45-degree field of view — 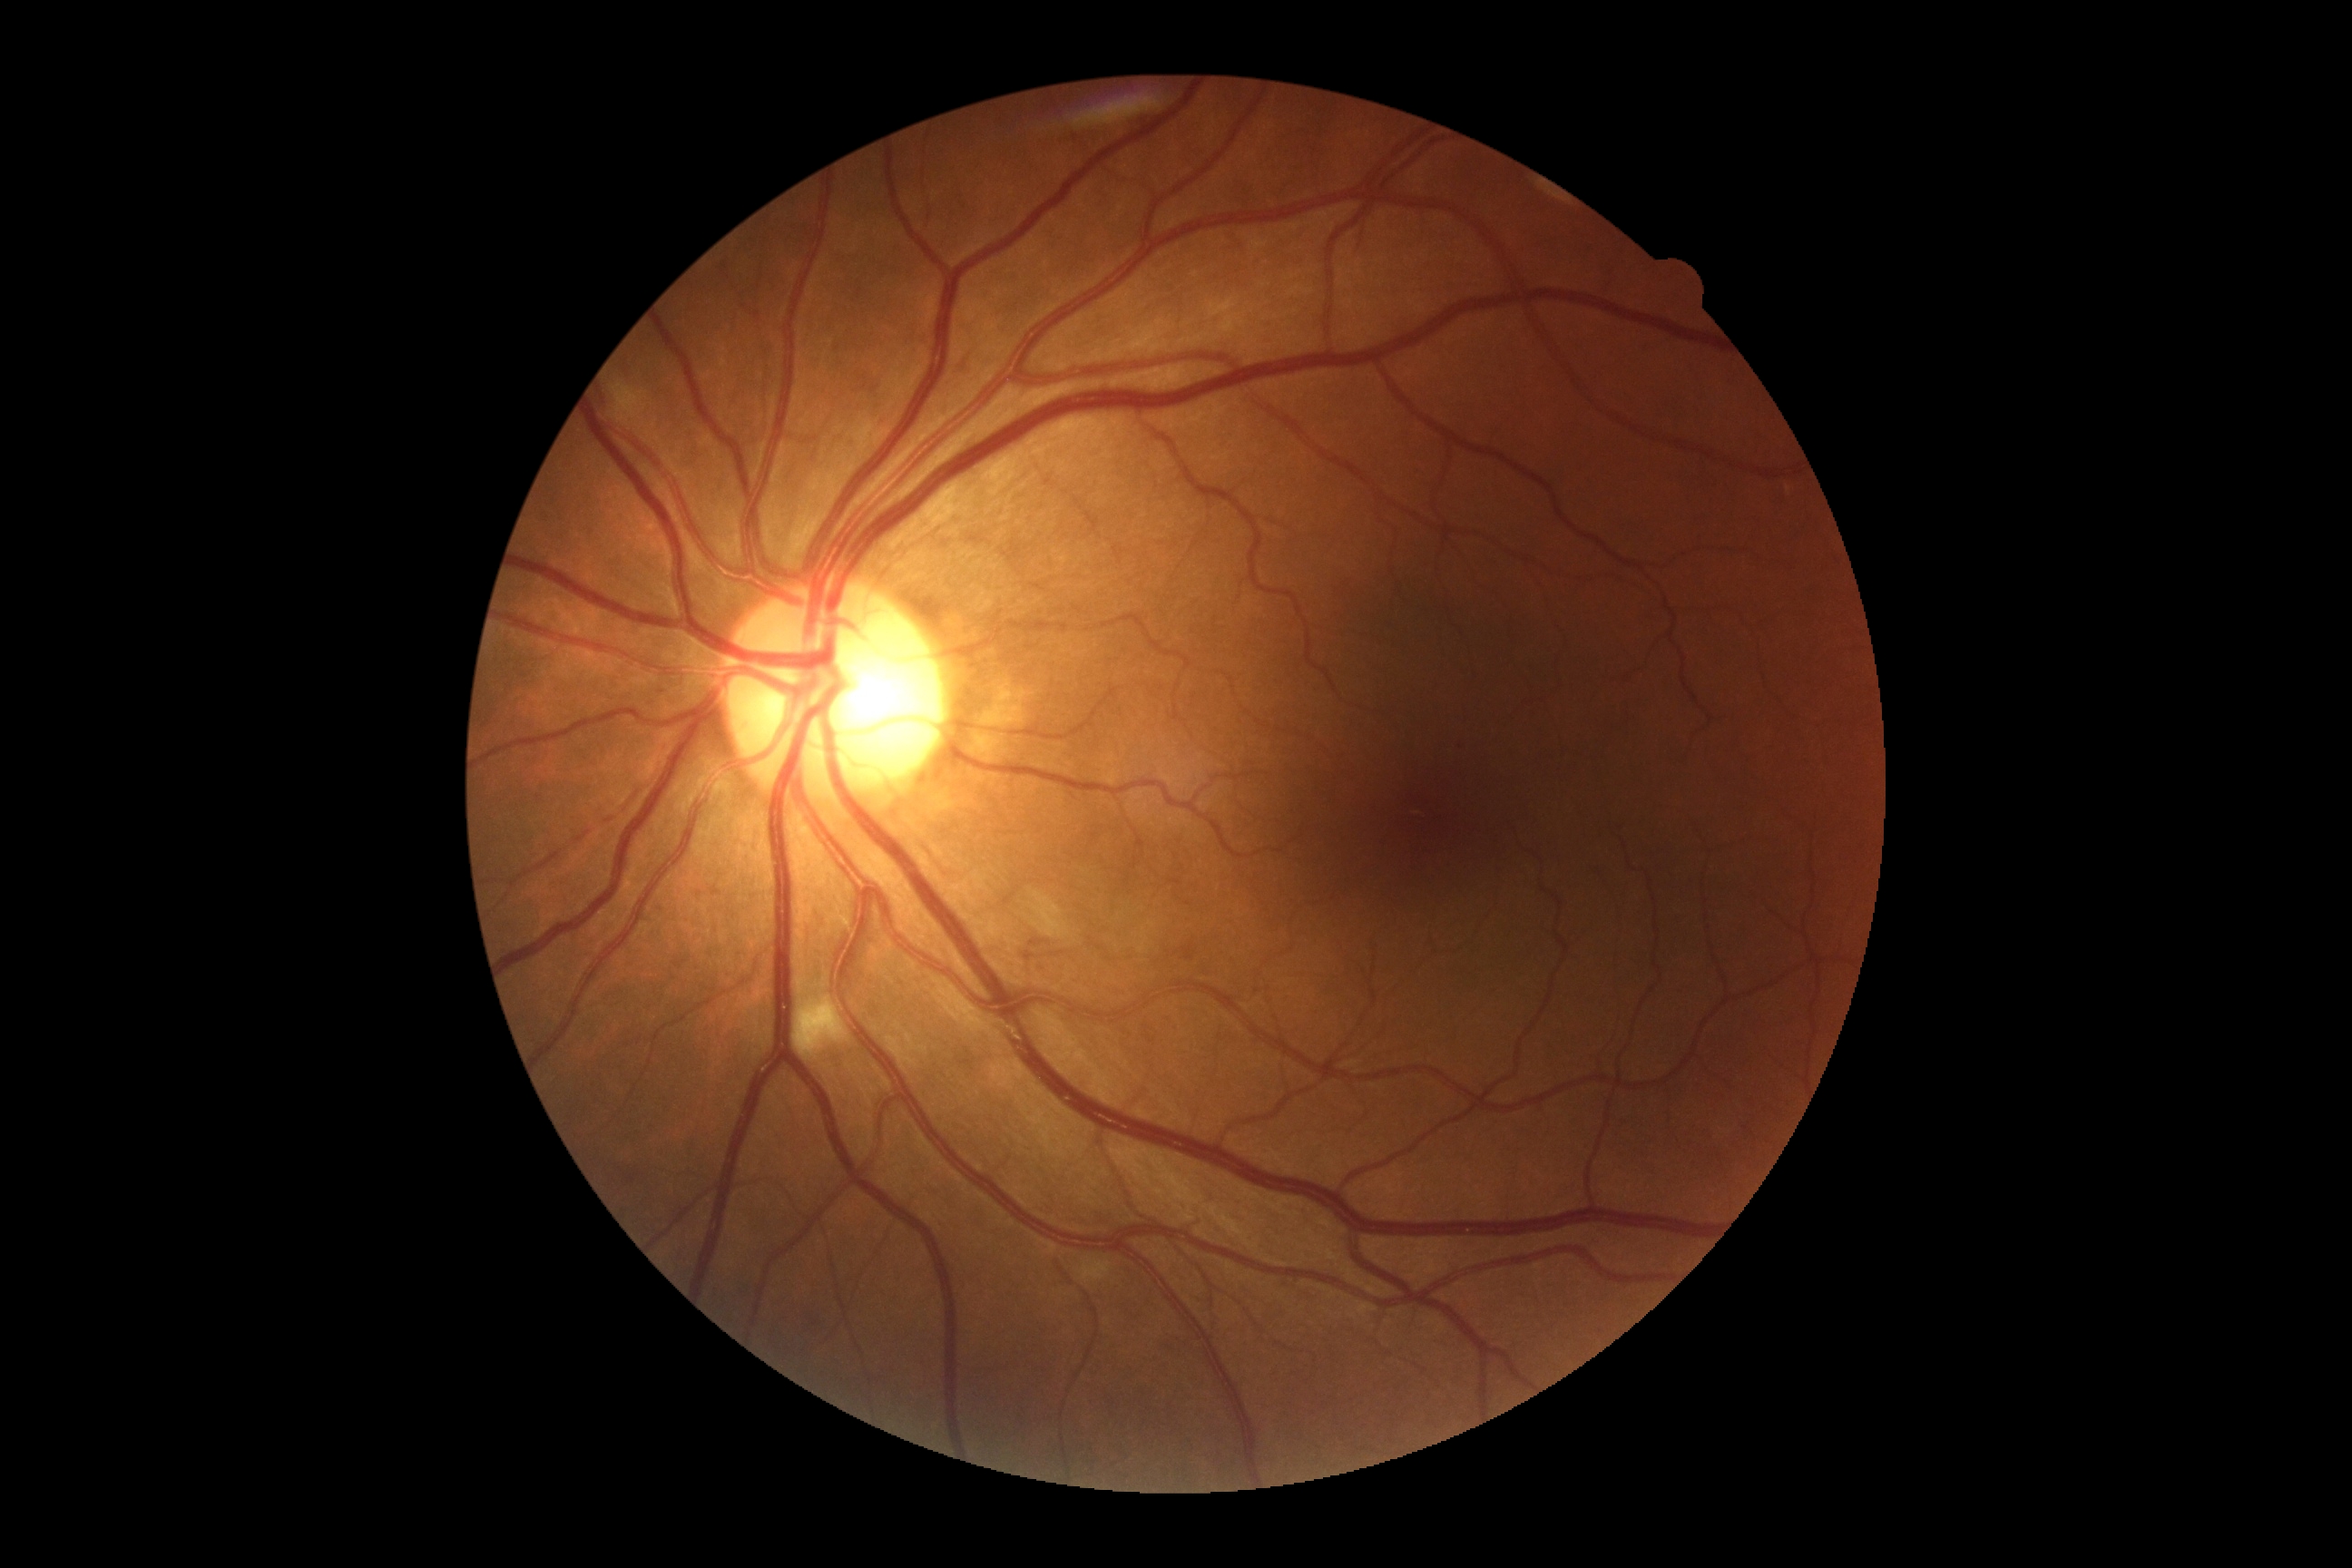 diabetic retinopathy severity = grade 2, DR class = non-proliferative diabetic retinopathy.